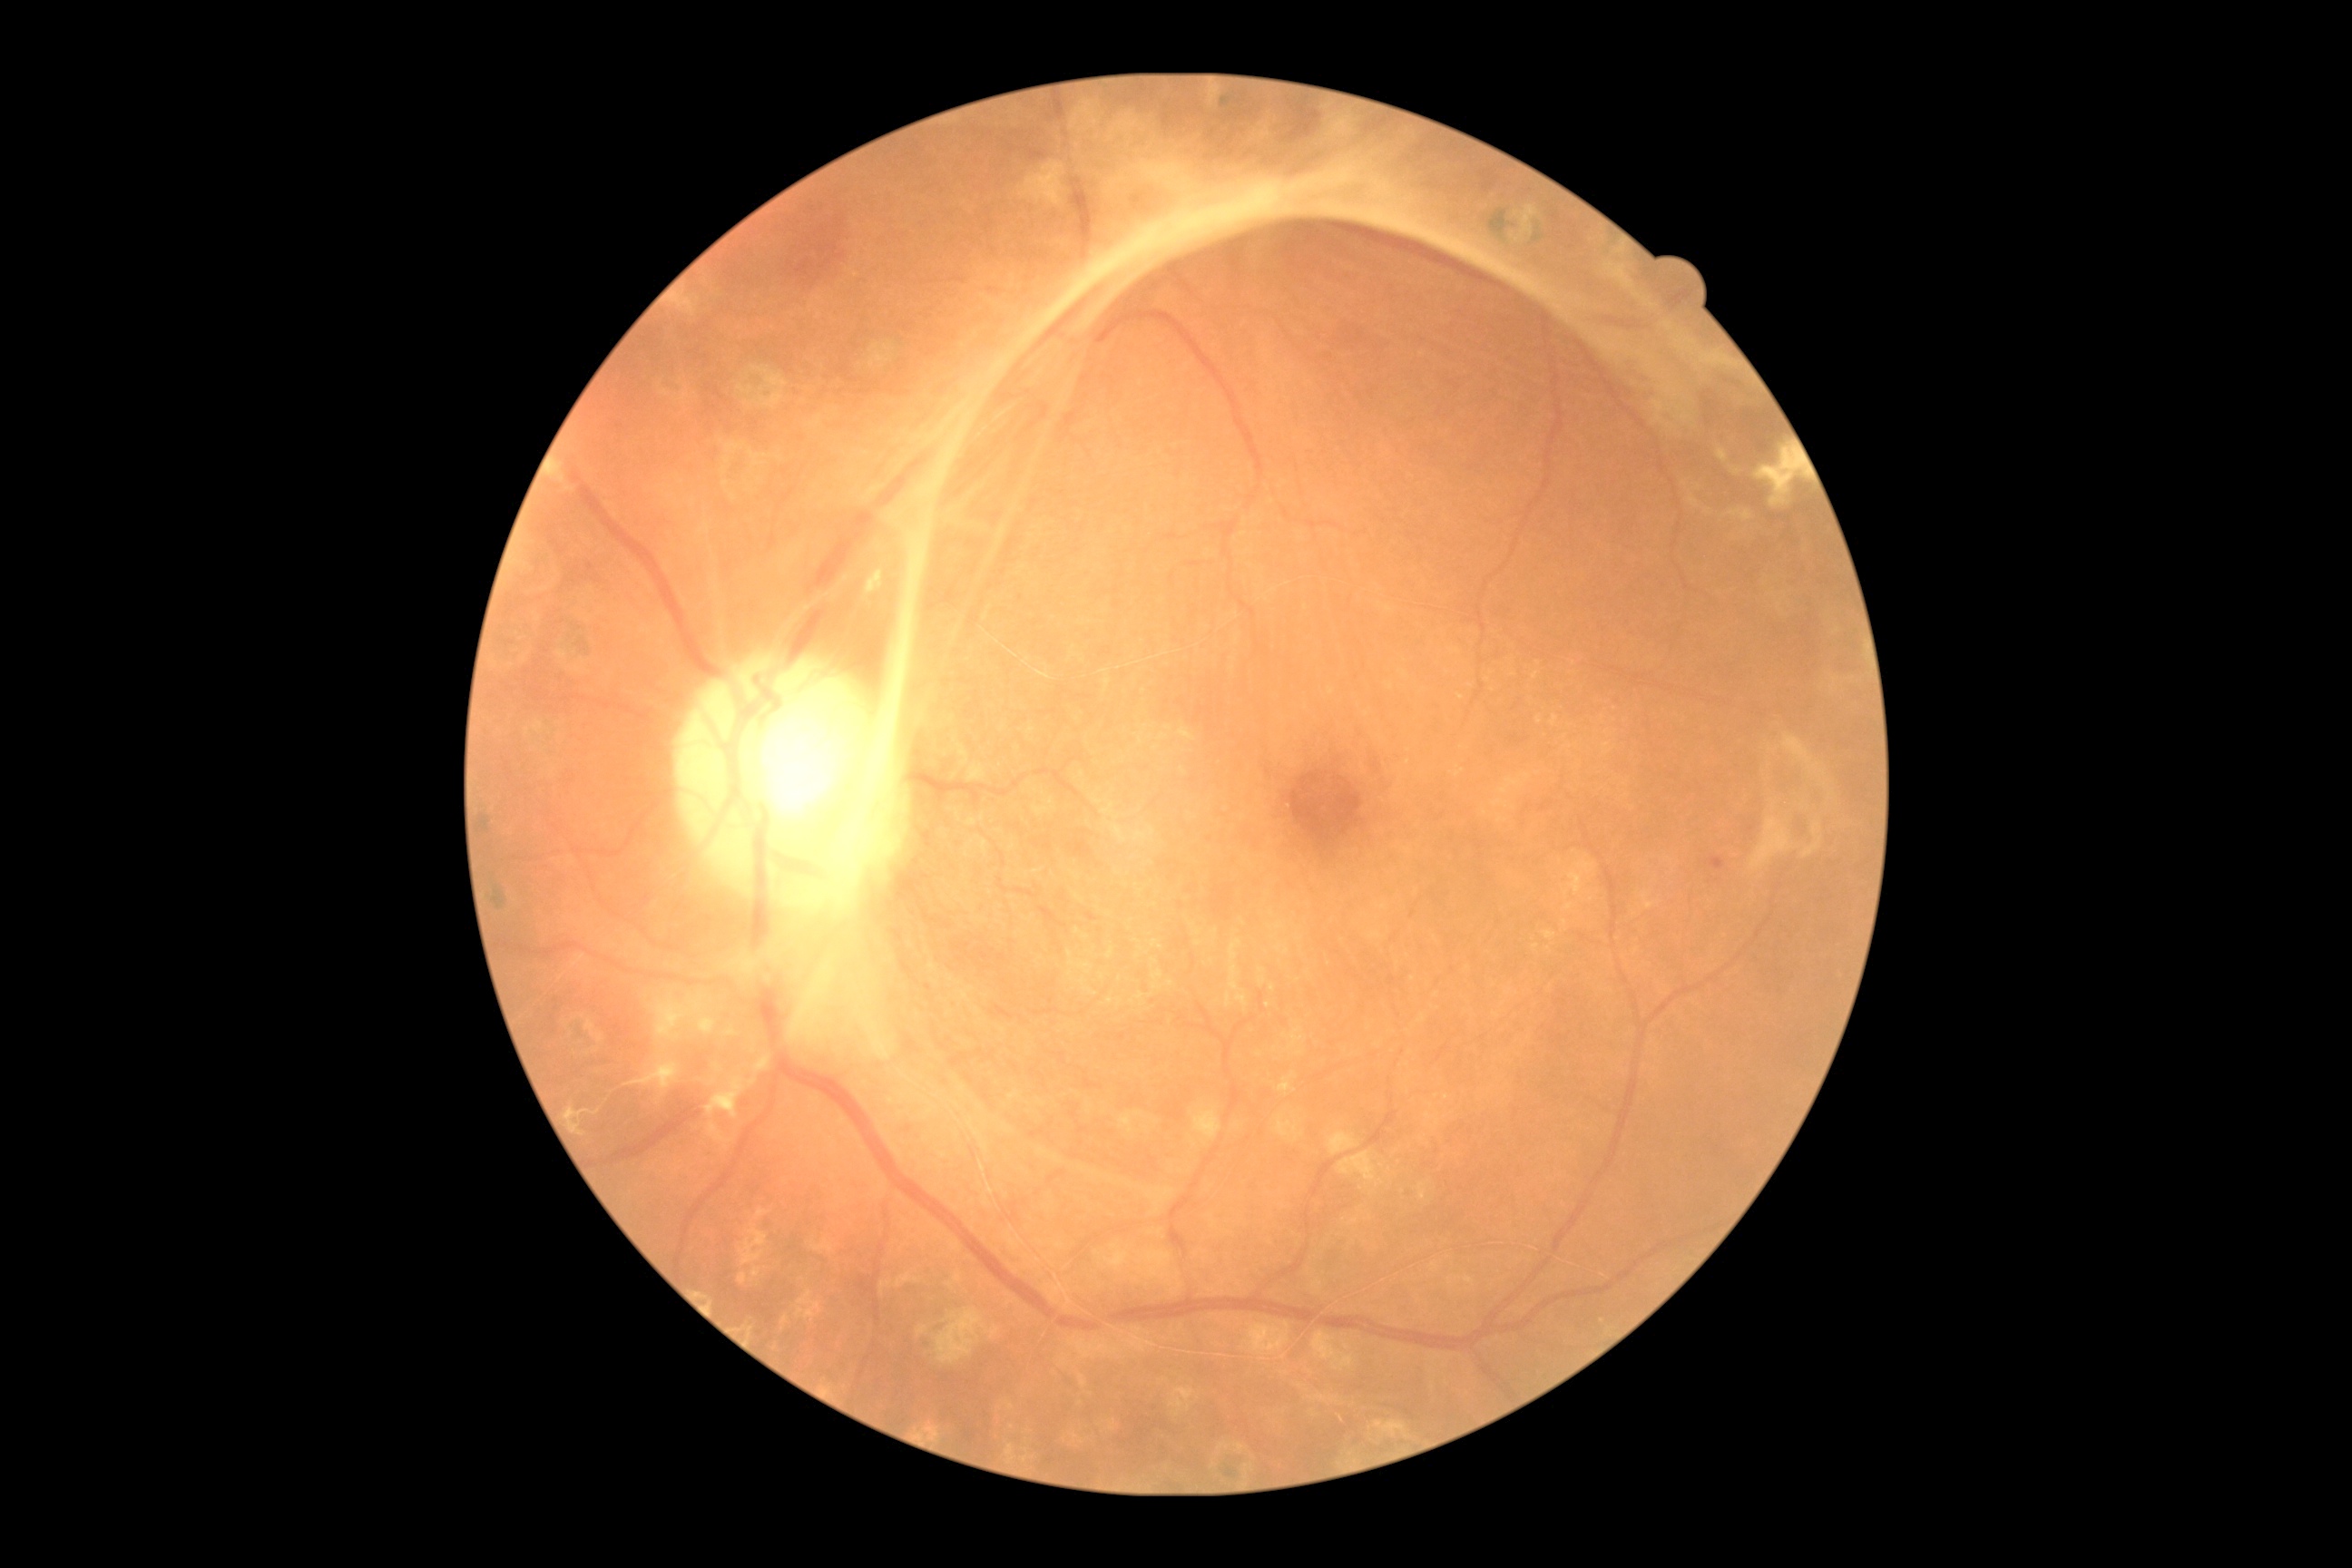 Diabetic retinopathy grade is 4.